45 degree fundus photograph · 848x848px: 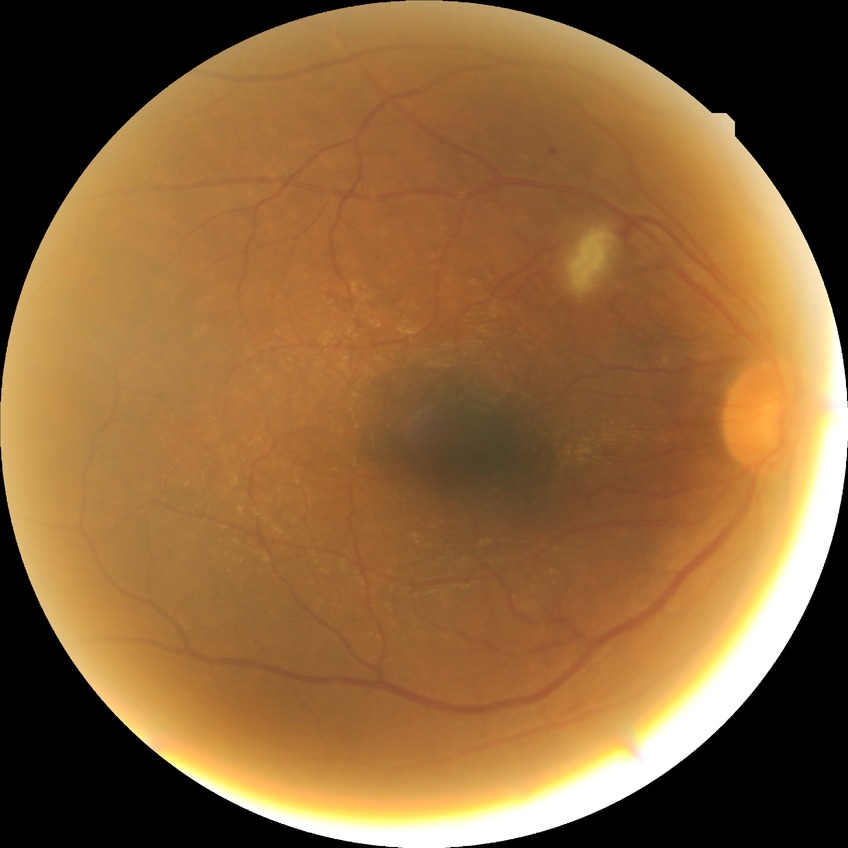 diabetic retinopathy severity = no diabetic retinopathy.